RetCam wide-field infant fundus image: 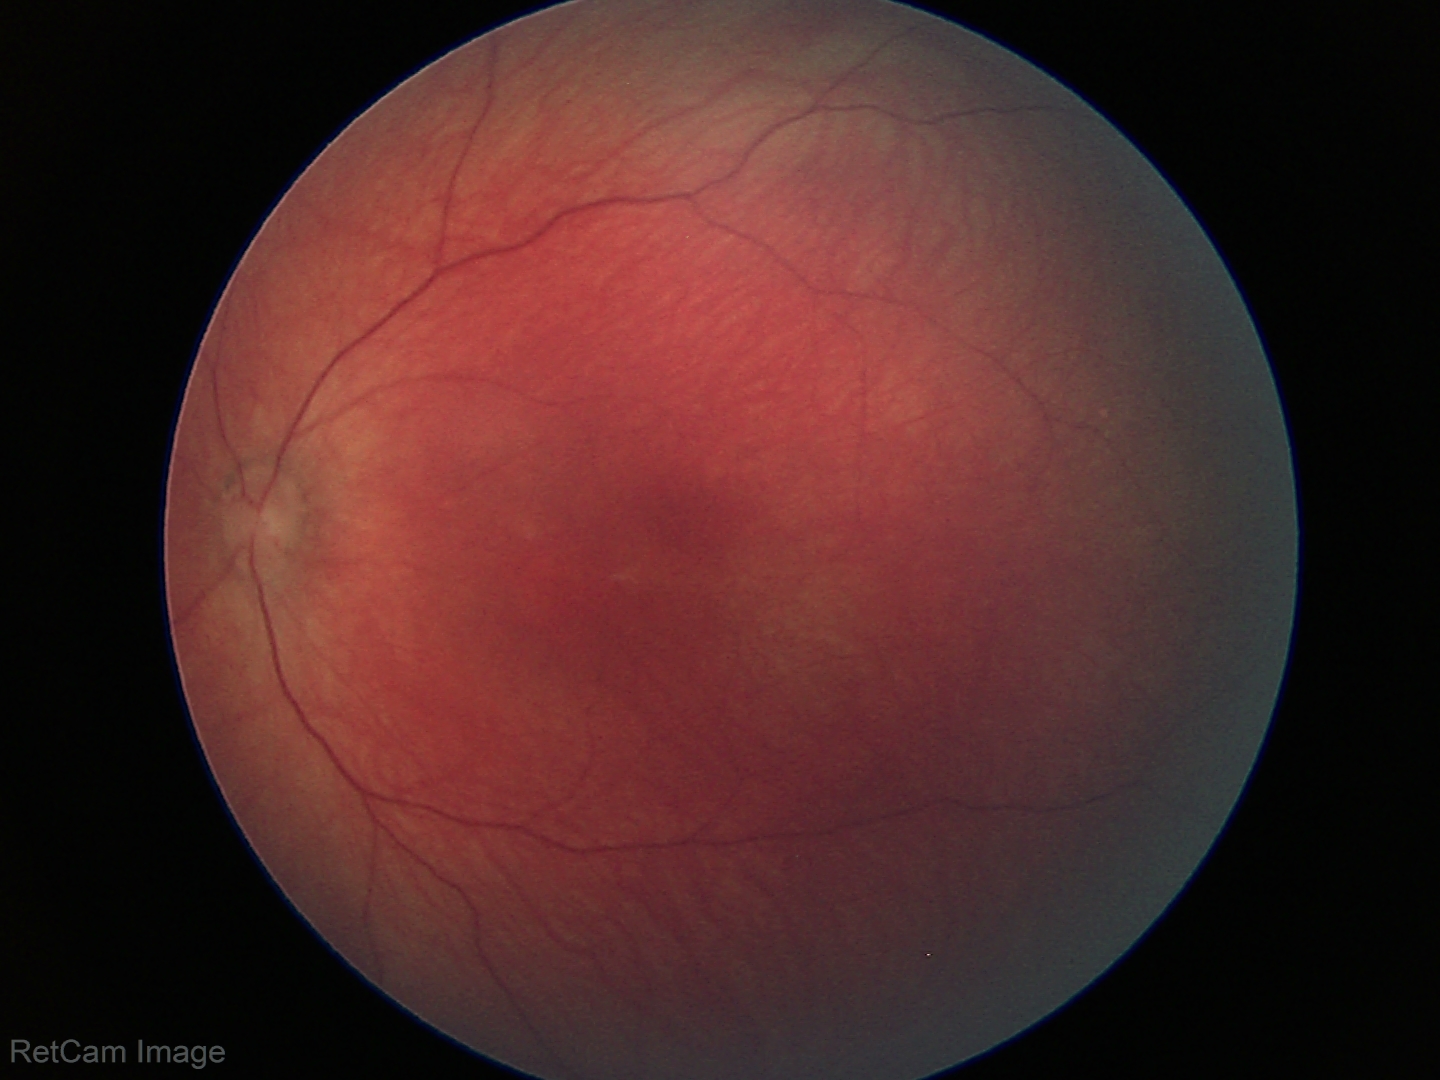
Normal screening examination.